DR severity per modified Davis staging.
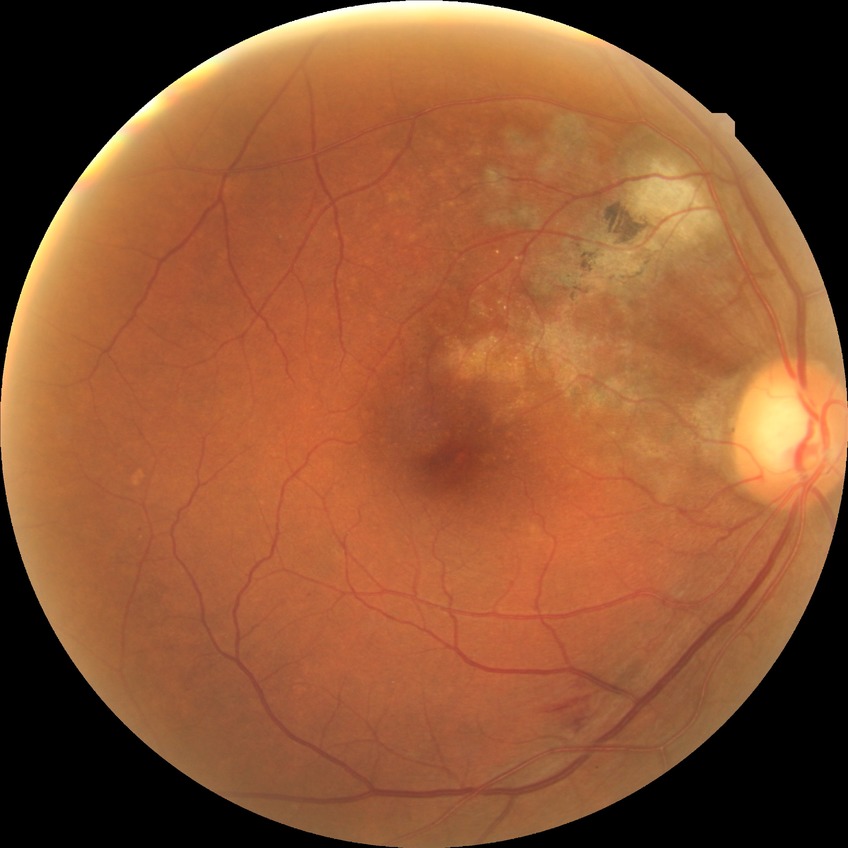 Retinopathy stage: simple diabetic retinopathy.